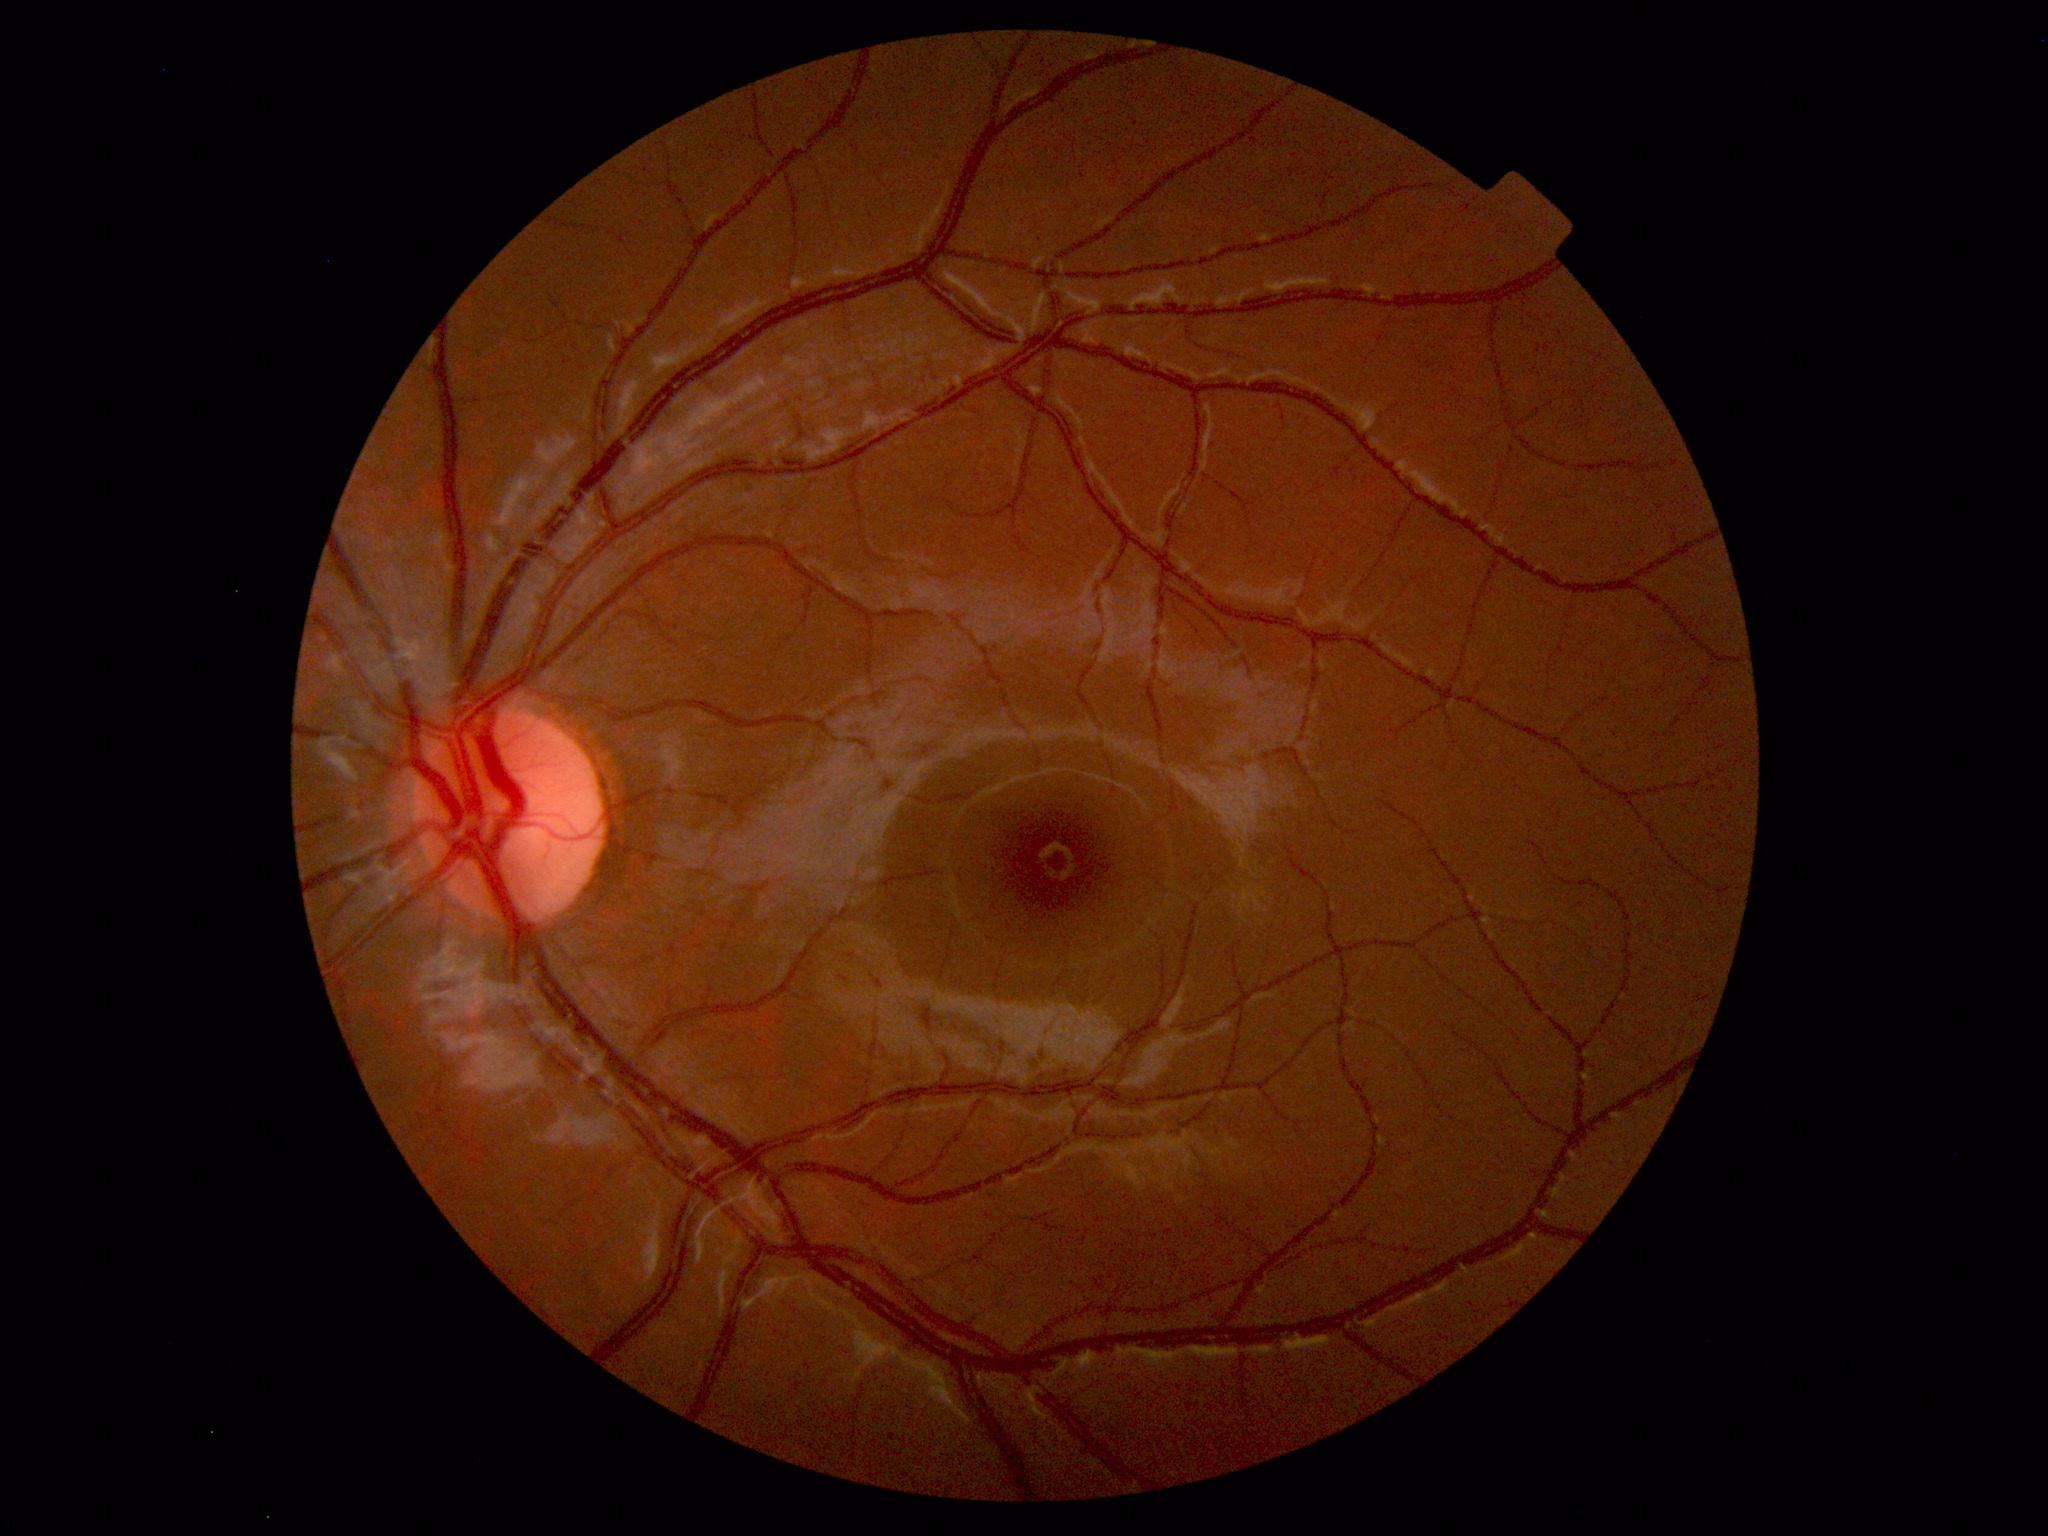
Normal fundus. No pathology identified.